Fundus photo, acquired with a NIDEK AFC-230, no pharmacologic dilation: 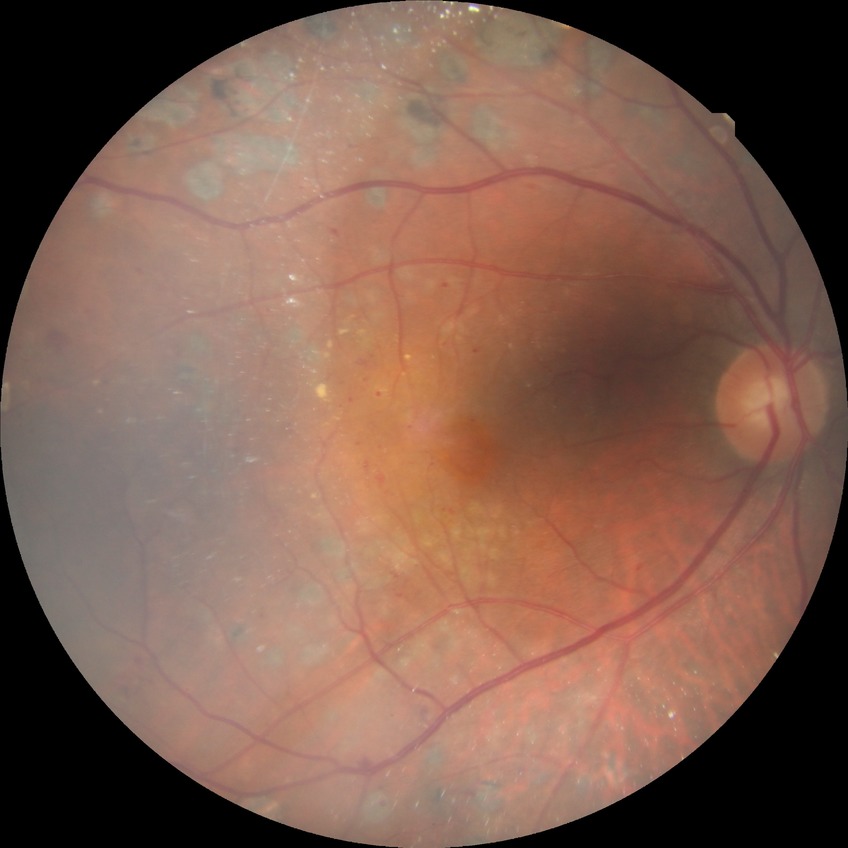
Retinopathy stage is proliferative diabetic retinopathy.